45-degree field of view — 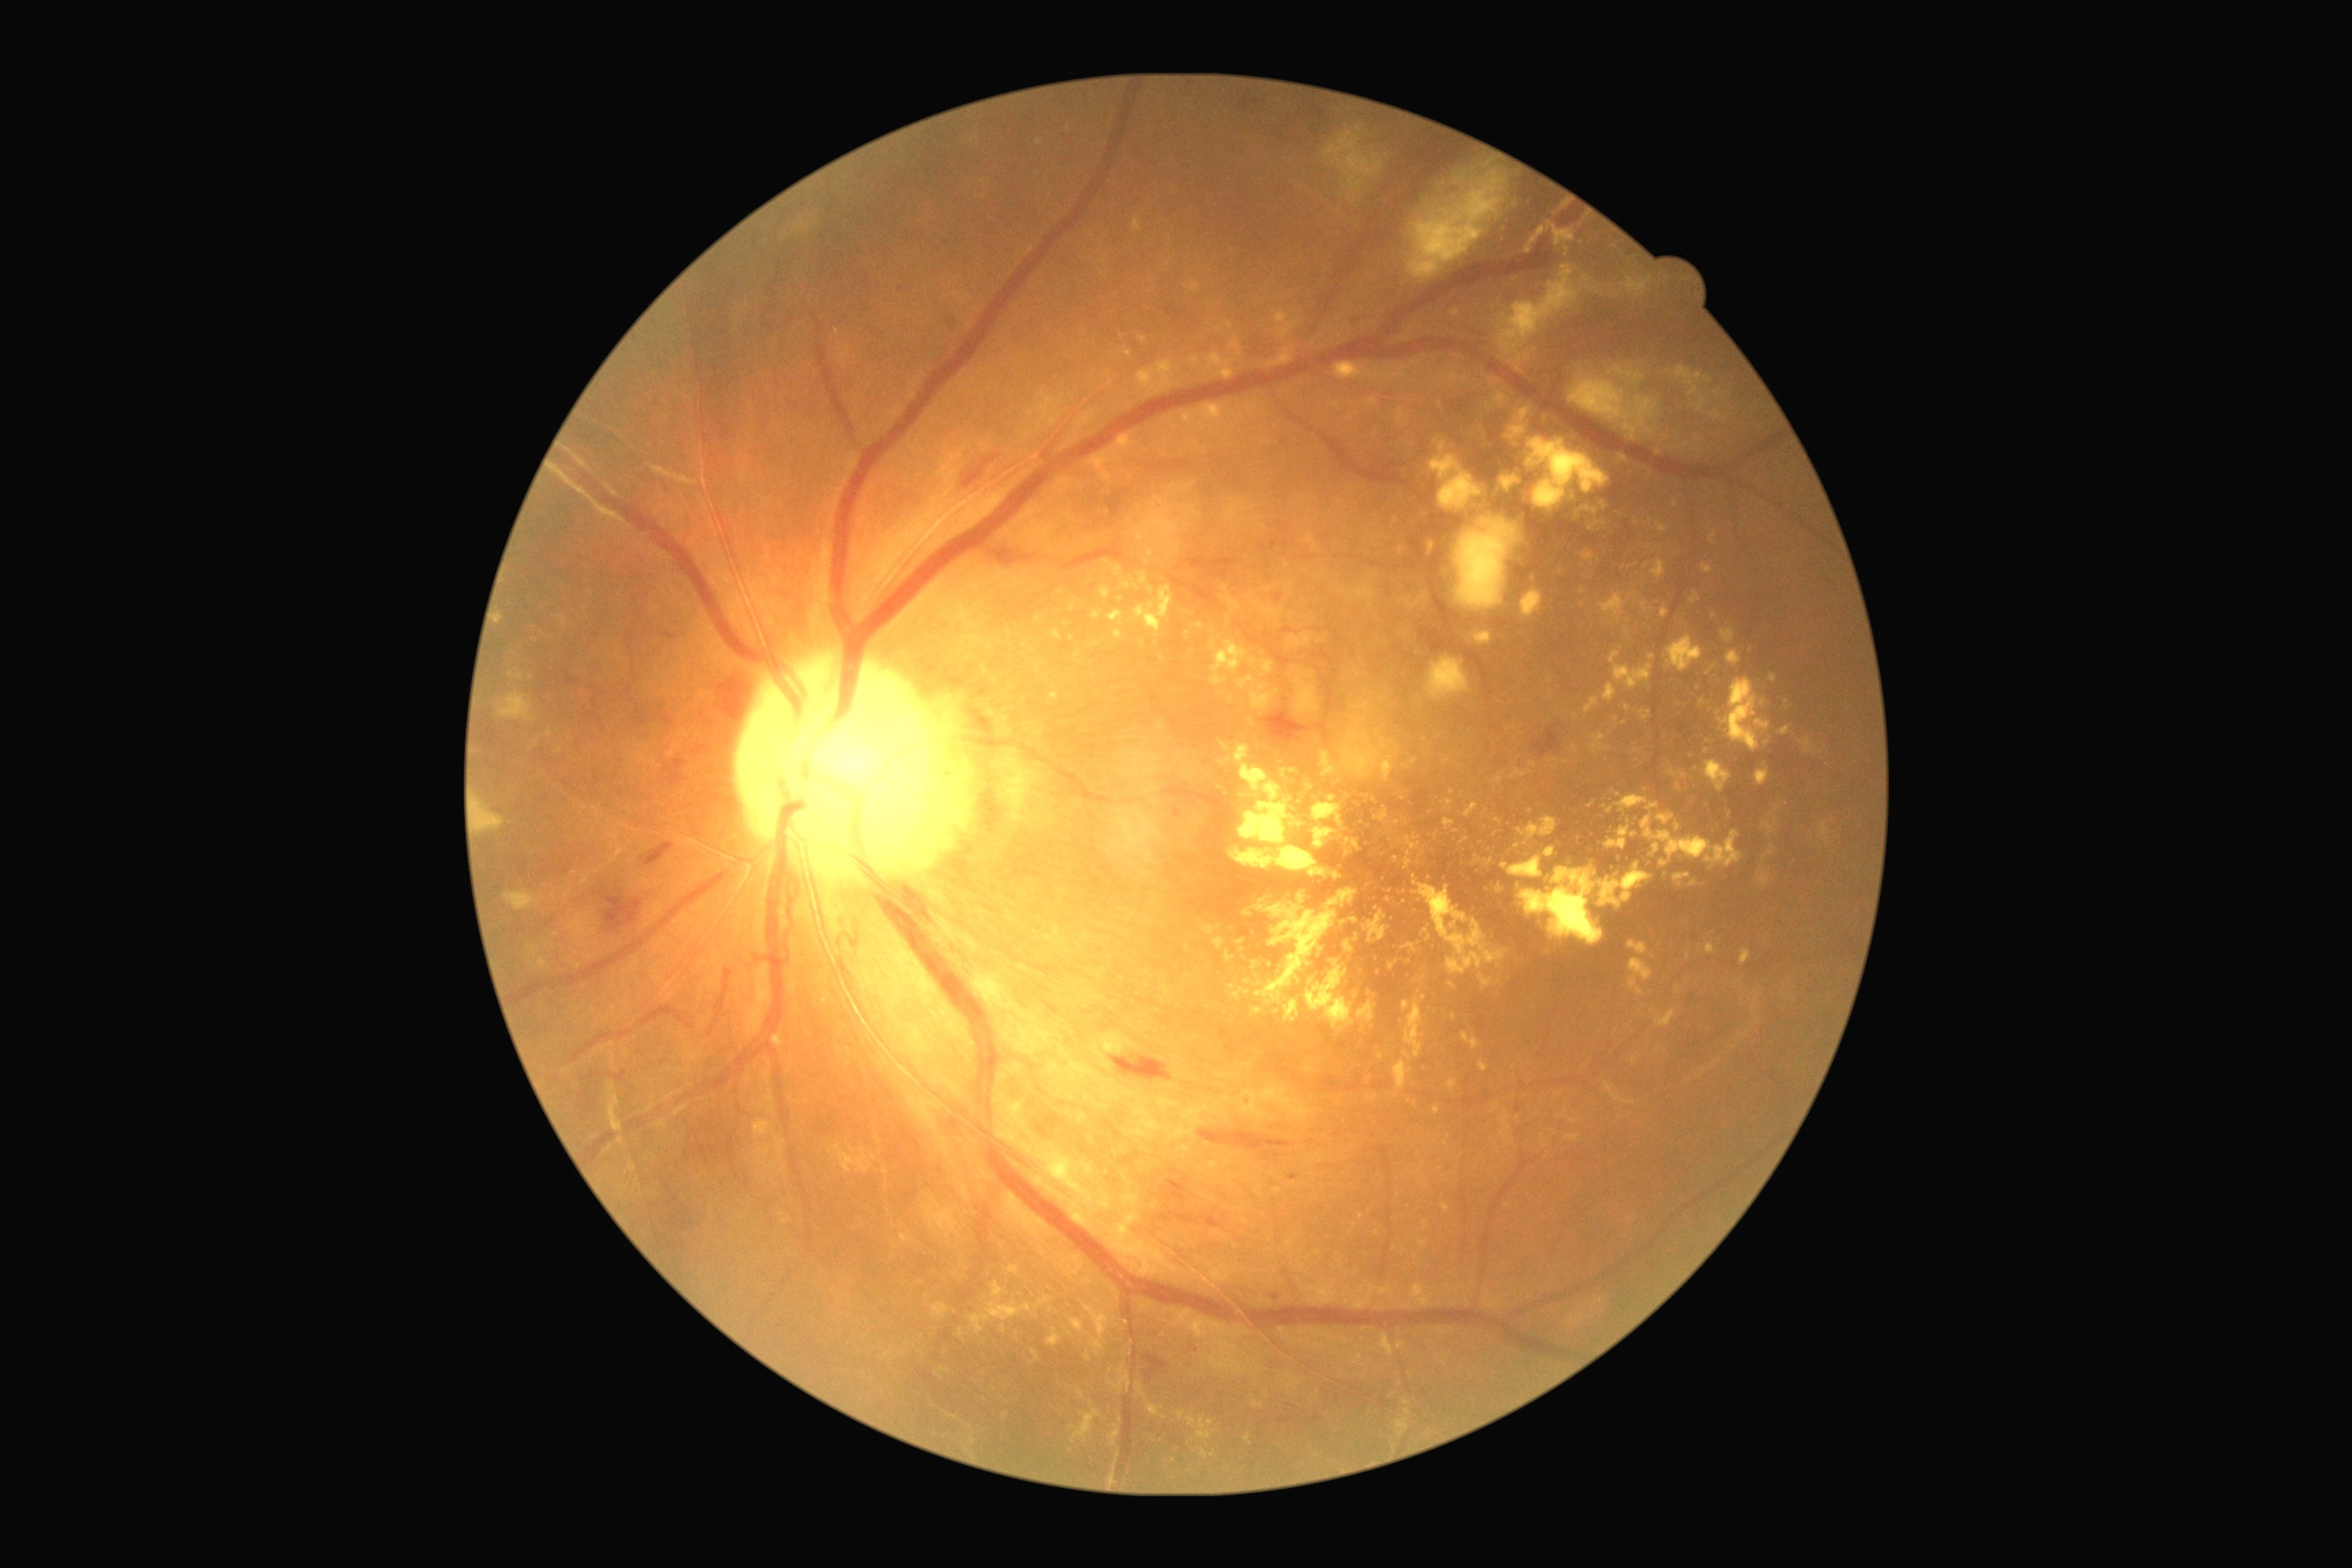

• retinopathy grade: 2 (moderate NPDR)